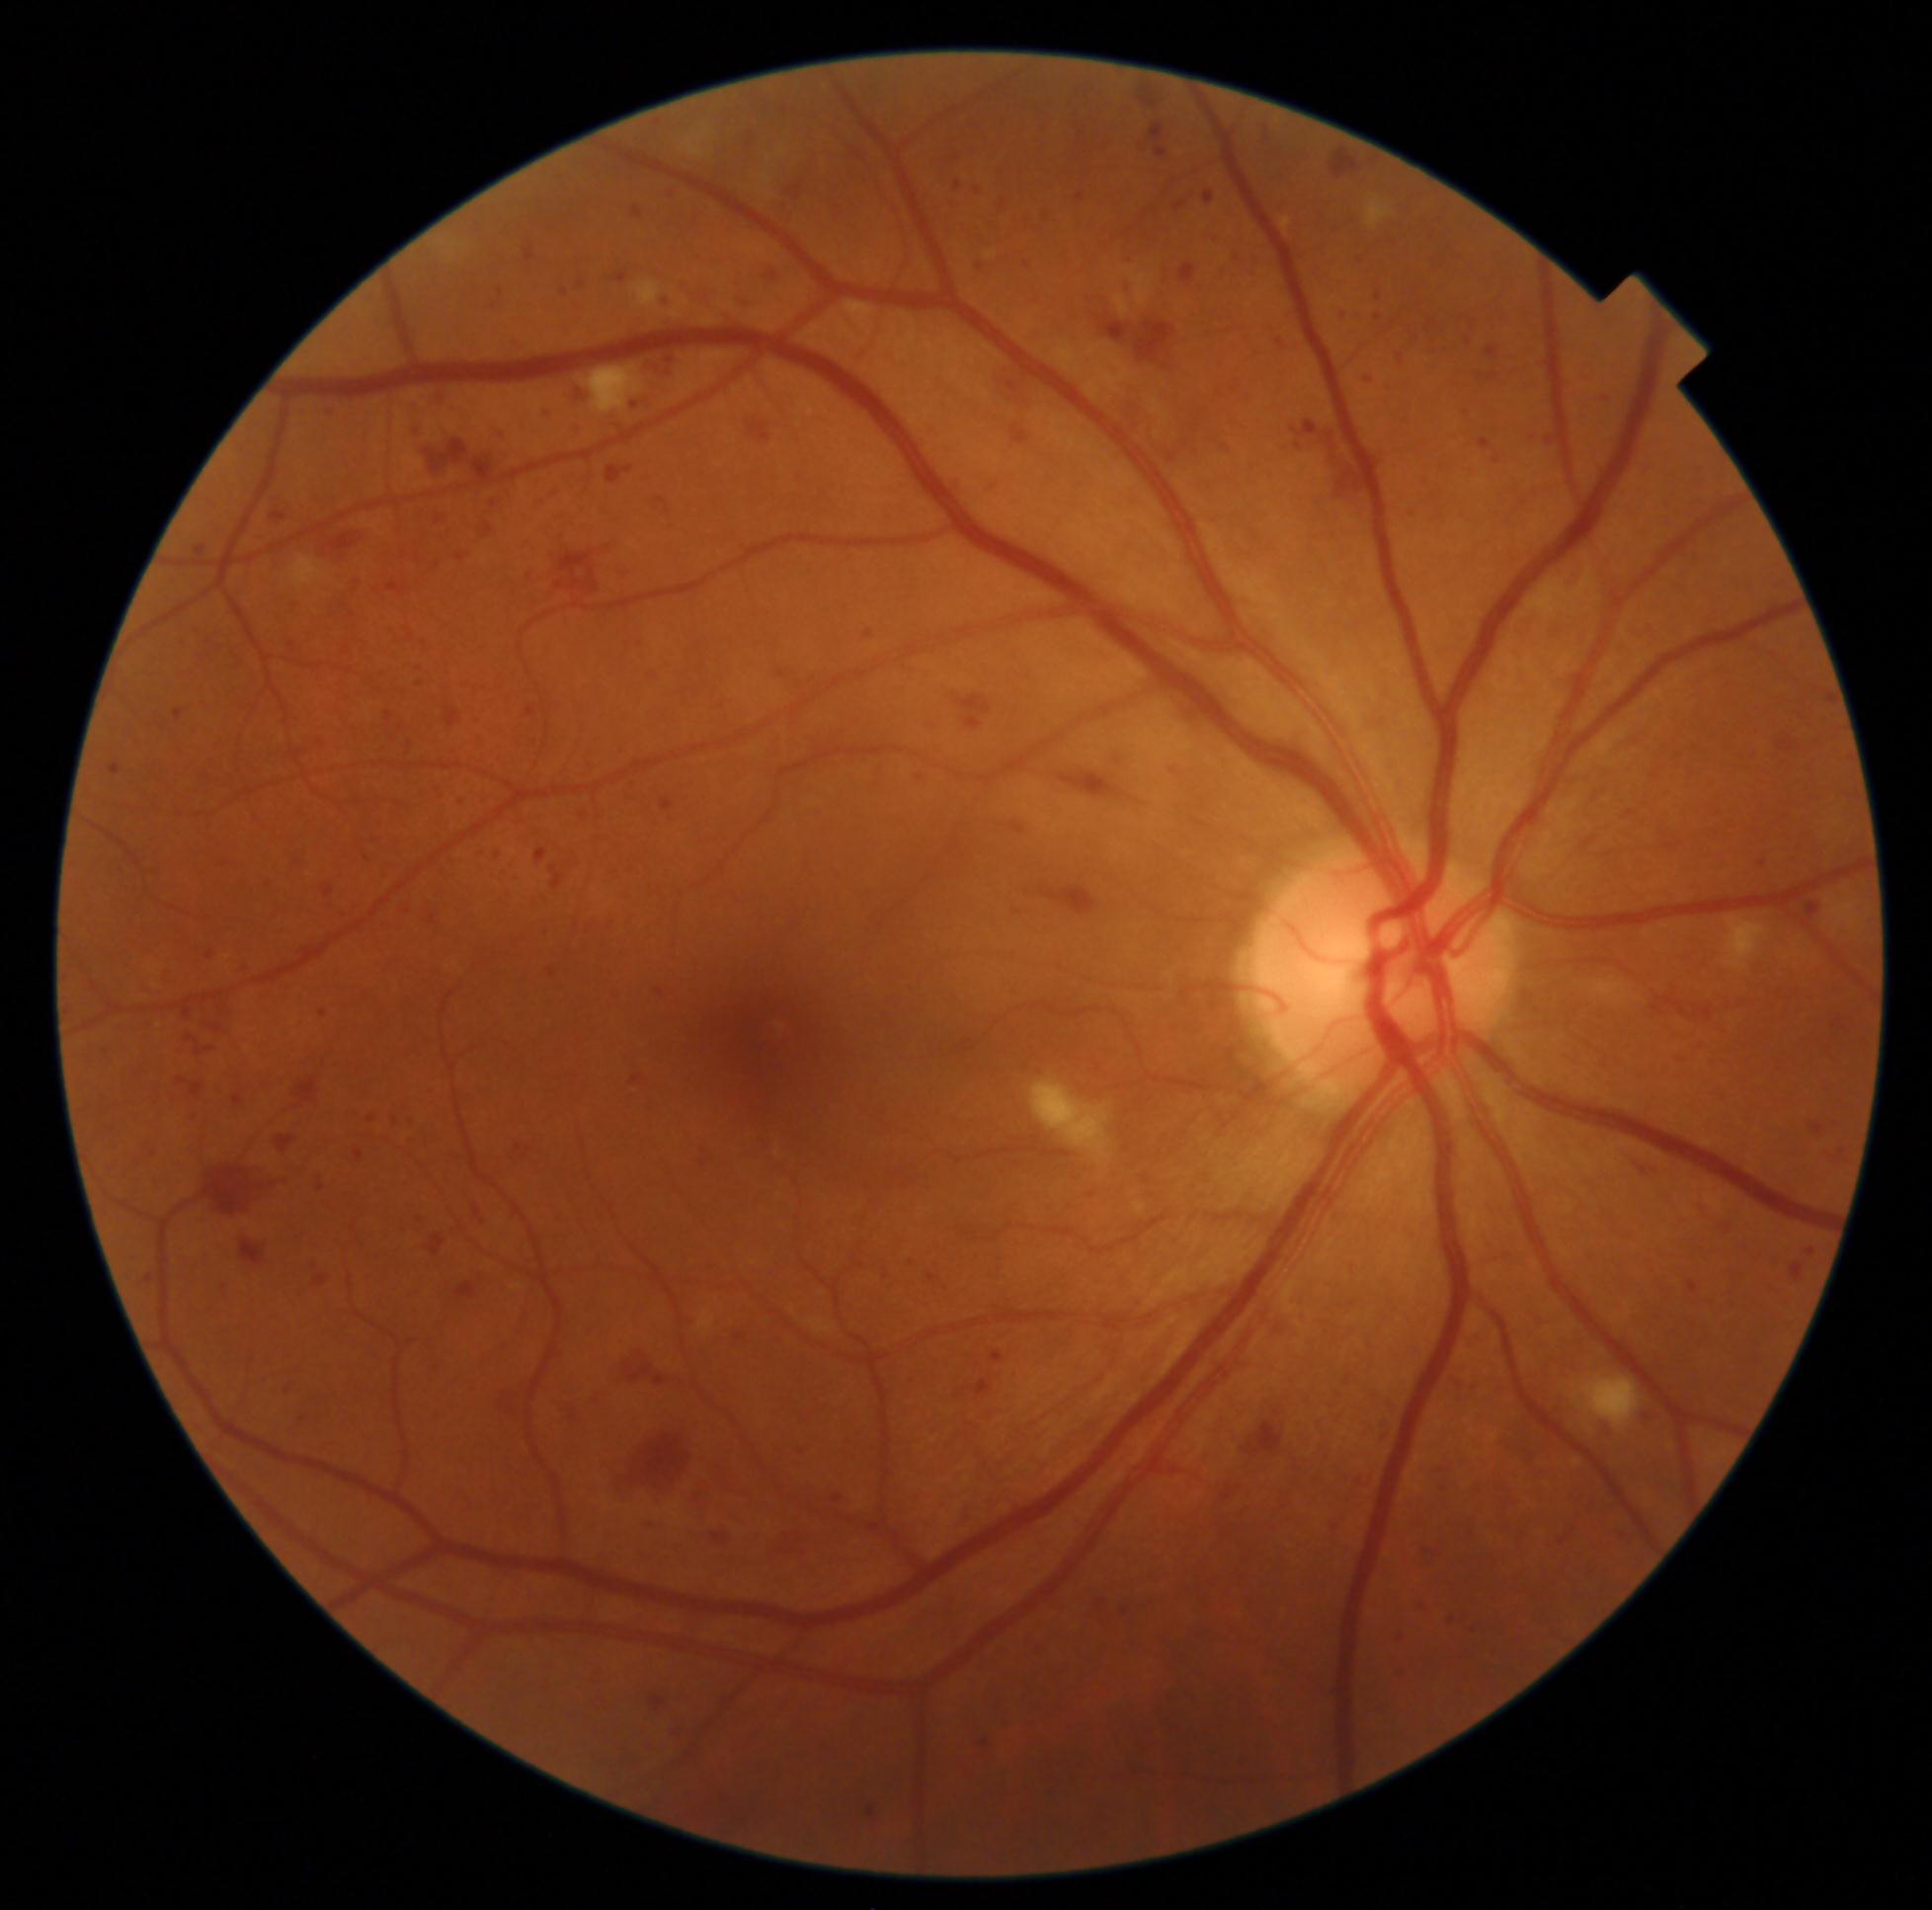 <lesions partial="true">
  <dr_grade>3</dr_grade>
  <he partial="true">x1=1393, y1=350, x2=1406, y2=367 | x1=413, y1=662, x2=425, y2=671 | x1=195, y1=865, x2=207, y2=881 | x1=696, y1=1436, x2=784, y2=1522 | x1=1481, y1=312, x2=1509, y2=335 | x1=607, y1=465, x2=634, y2=485 | x1=612, y1=985, x2=625, y2=1004 | x1=952, y1=1498, x2=981, y2=1534 | x1=641, y1=1520, x2=668, y2=1531 | x1=663, y1=799, x2=674, y2=812 | x1=109, y1=765, x2=123, y2=777 | x1=1110, y1=385, x2=1150, y2=435 | x1=413, y1=1213, x2=429, y2=1233 | x1=201, y1=945, x2=223, y2=963 | x1=320, y1=403, x2=340, y2=425 | x1=657, y1=990, x2=665, y2=997 | x1=484, y1=524, x2=495, y2=538 | x1=402, y1=1135, x2=424, y2=1151</he>
  <he_small>pt(411, 745) | pt(1103, 1603)</he_small>
</lesions>